Color fundus image
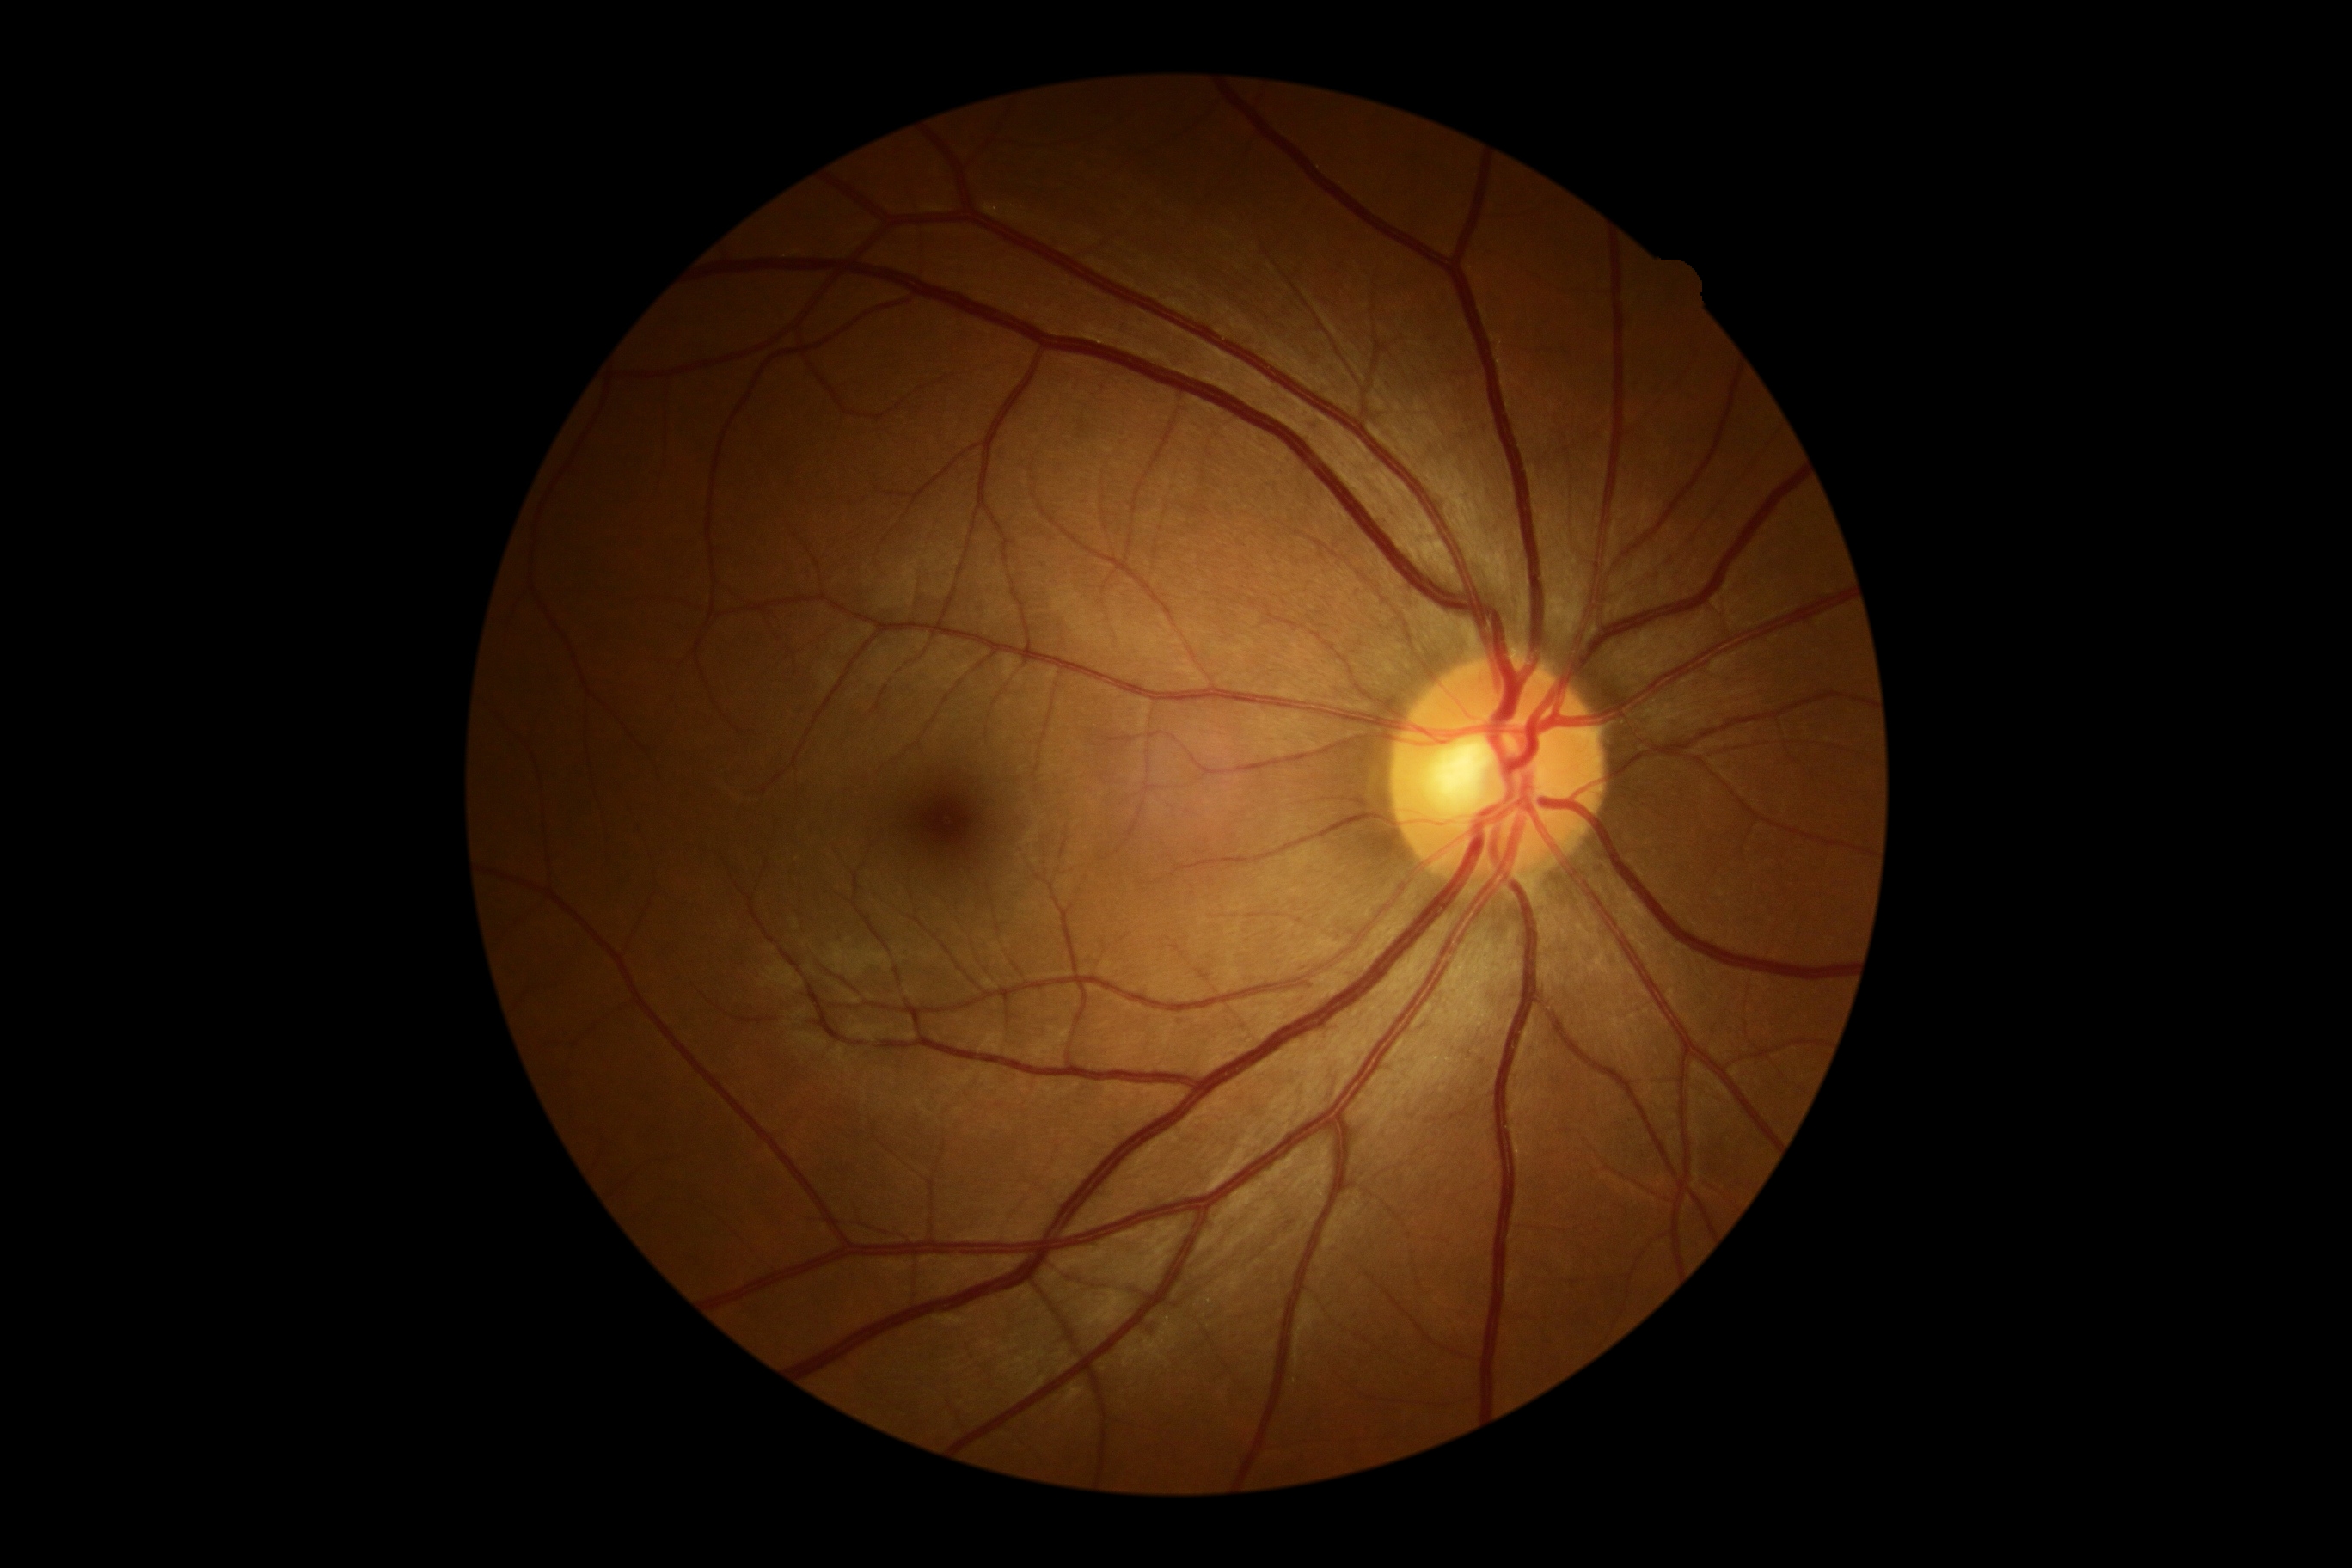
Diabetic retinopathy (DR) is grade 0 (no apparent retinopathy).
No apparent diabetic retinopathy.